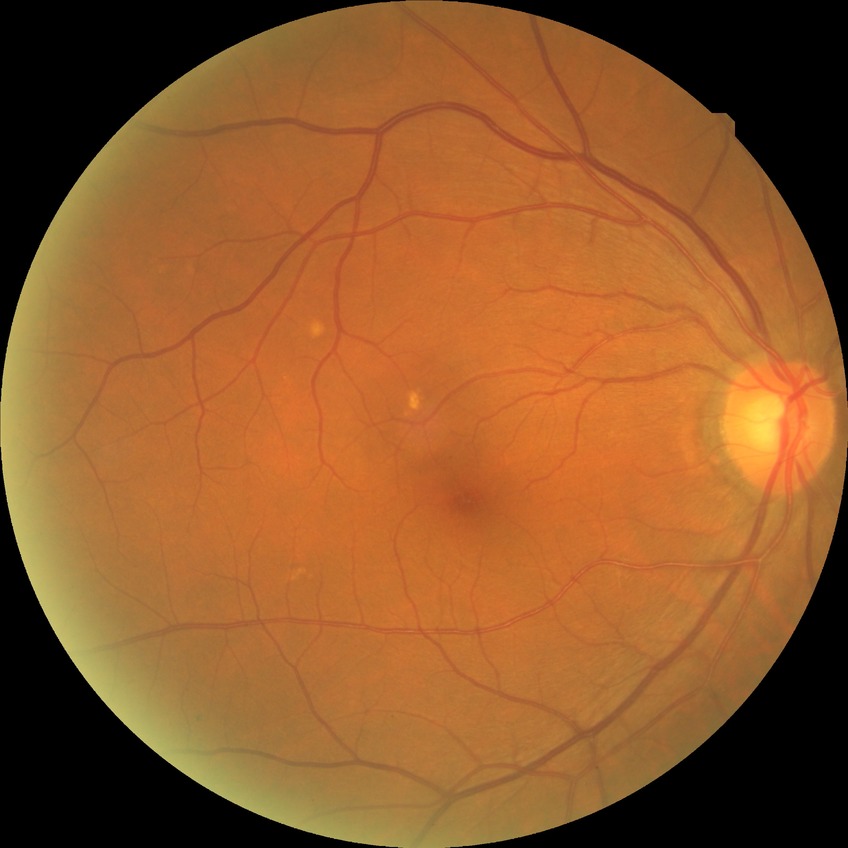 Modified Davis grading is no diabetic retinopathy.